45° FOV — 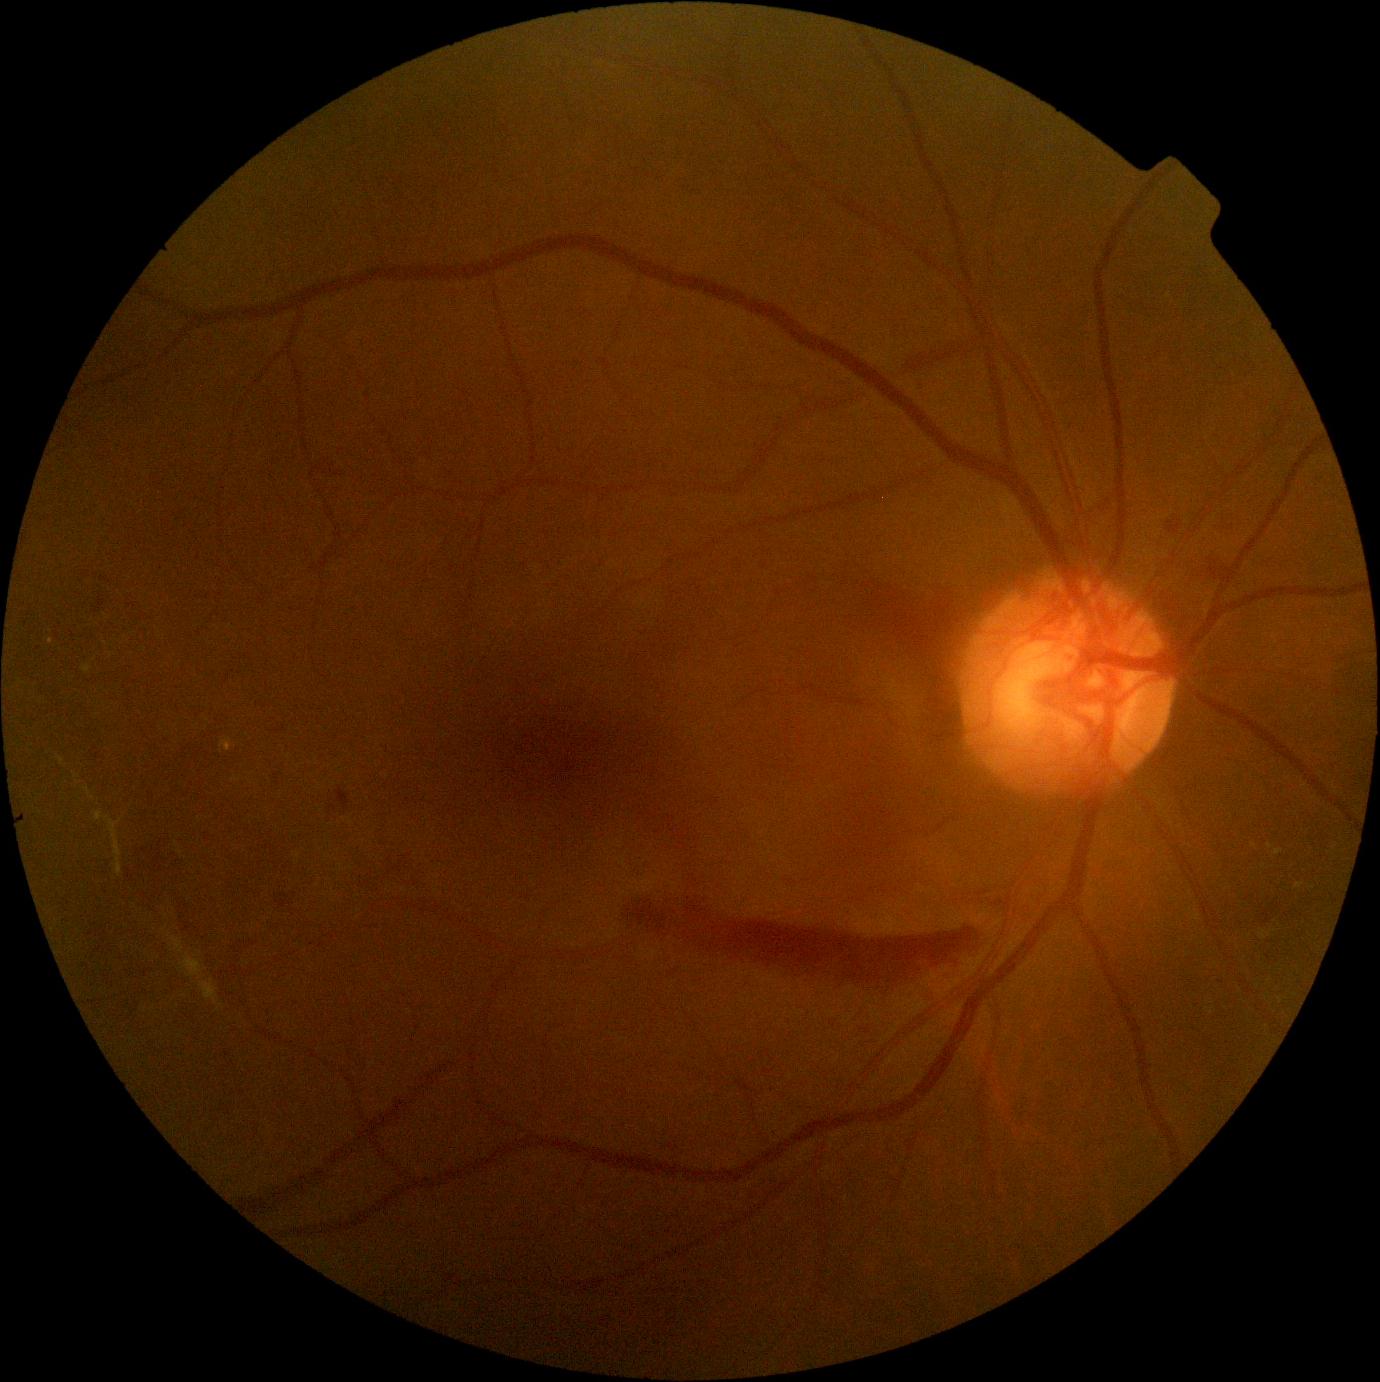 – DR grade: 4